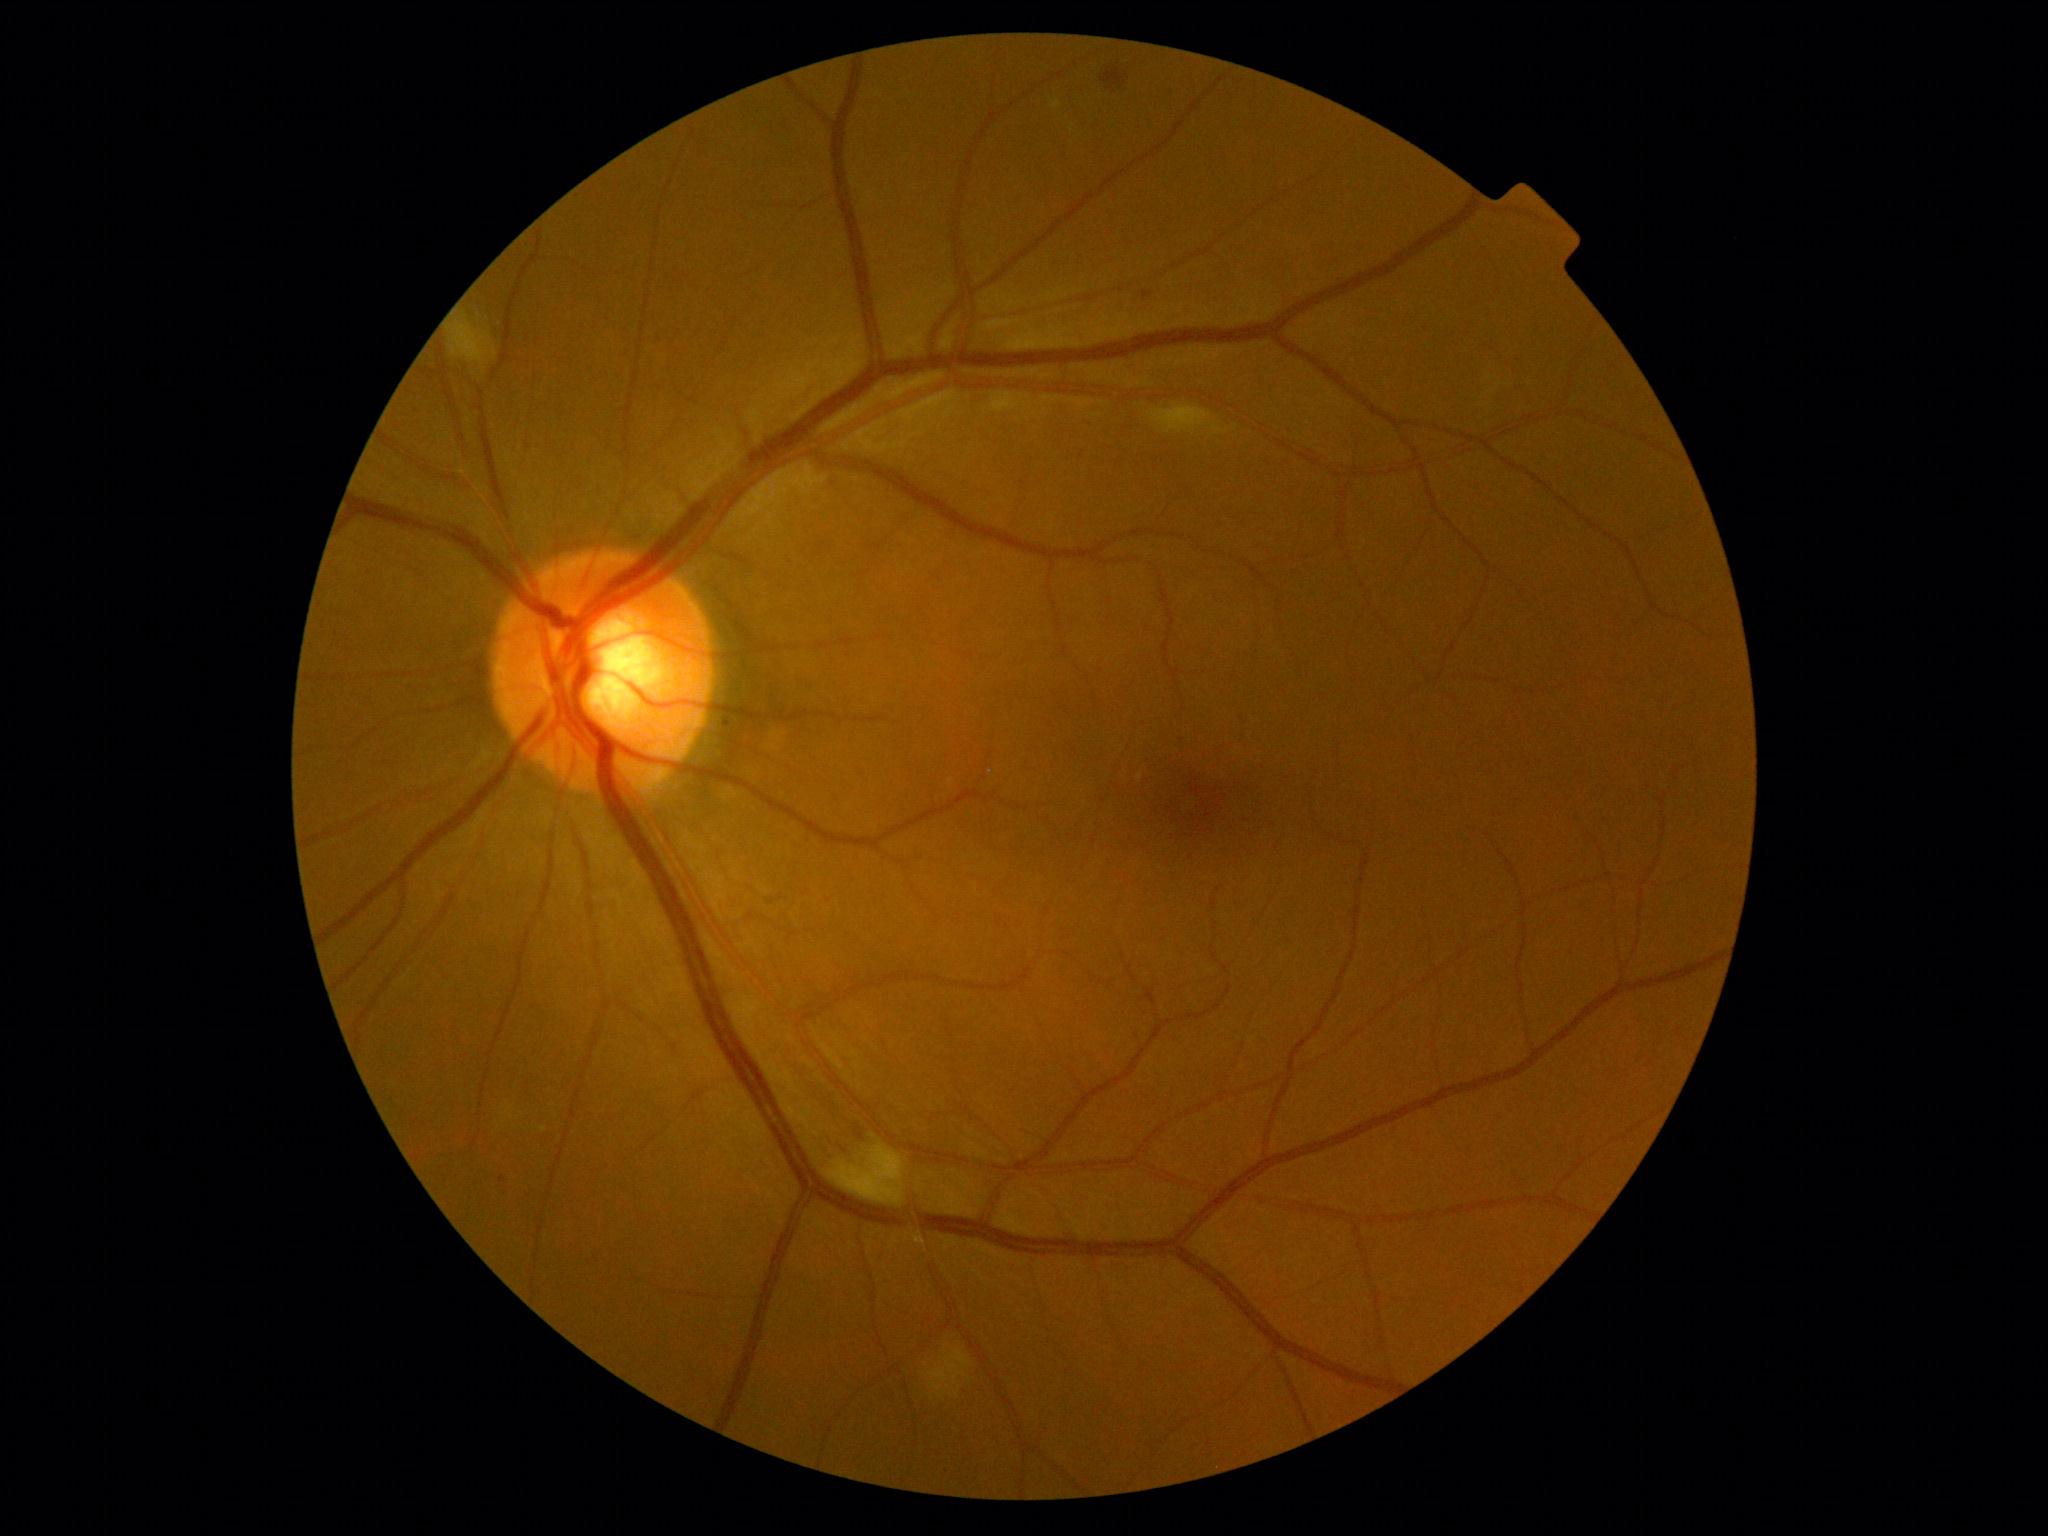
DR class@non-proliferative diabetic retinopathy; DR@grade 2.